45° field of view. Image size 2212x1659 — 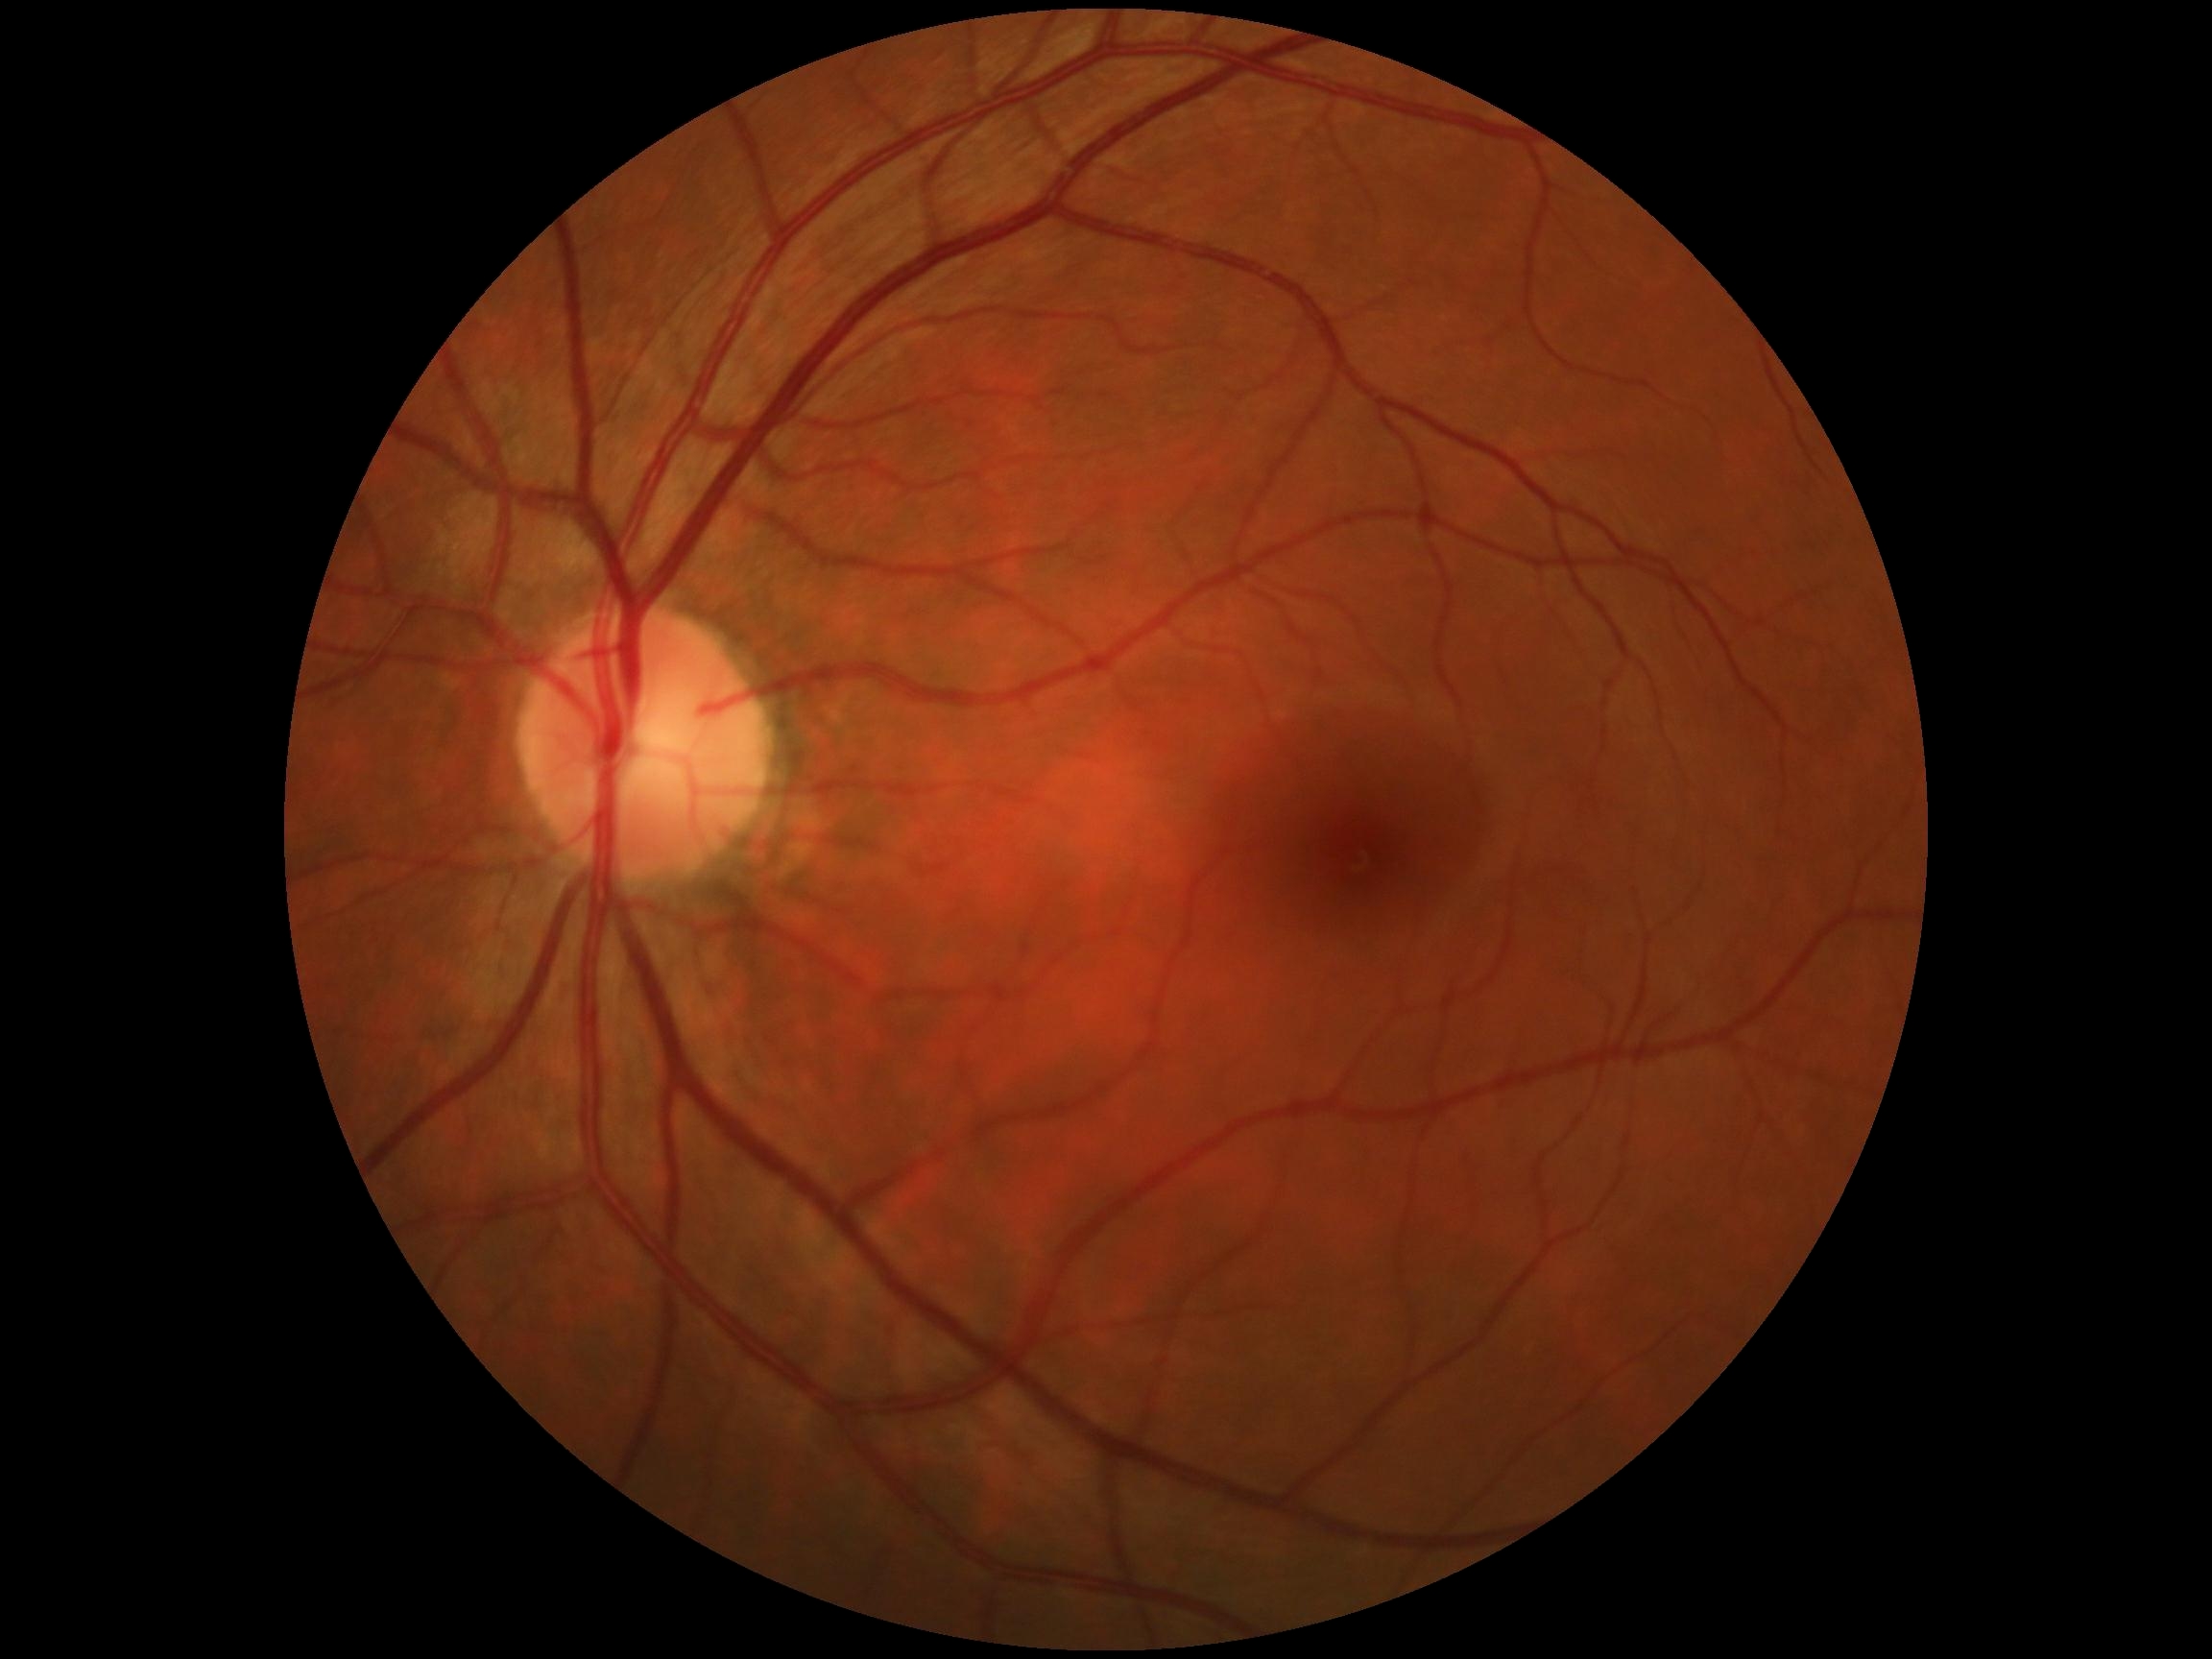
DR severity is grade 0.